45° FOV.
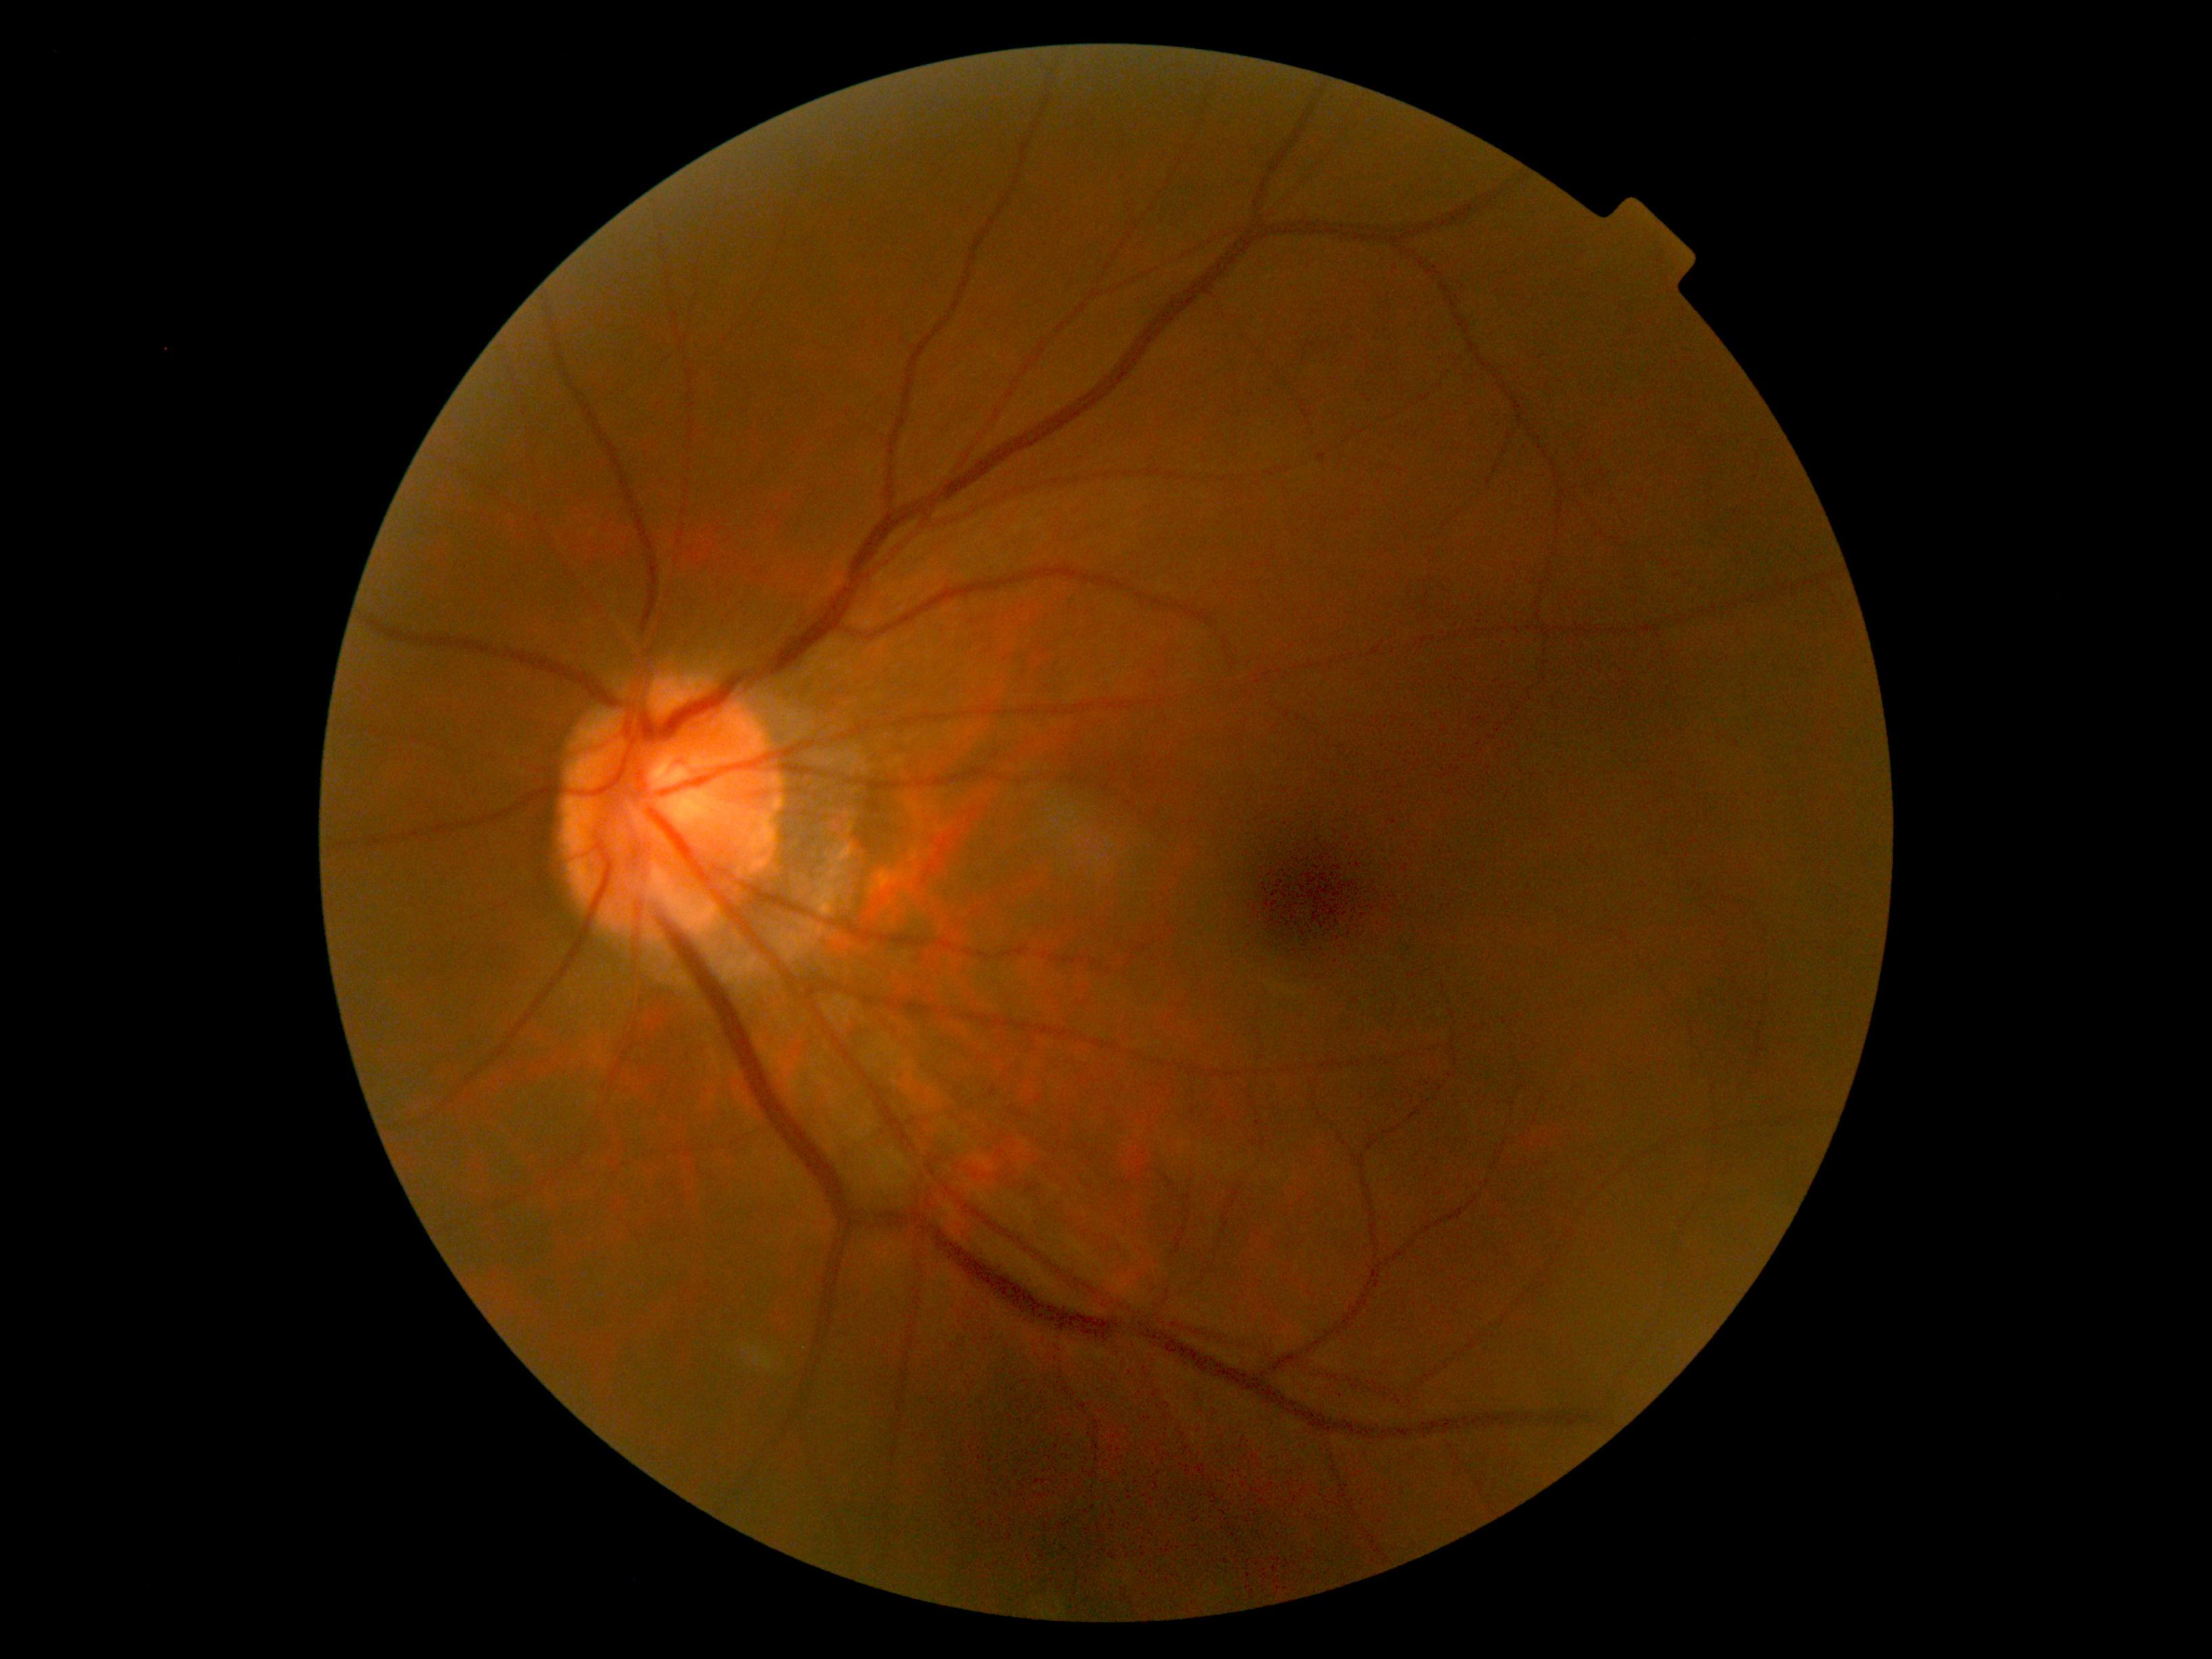

{"dr_impression": "no DR findings", "dr_grade": "no apparent retinopathy (grade 0) — no visible signs of diabetic retinopathy"}